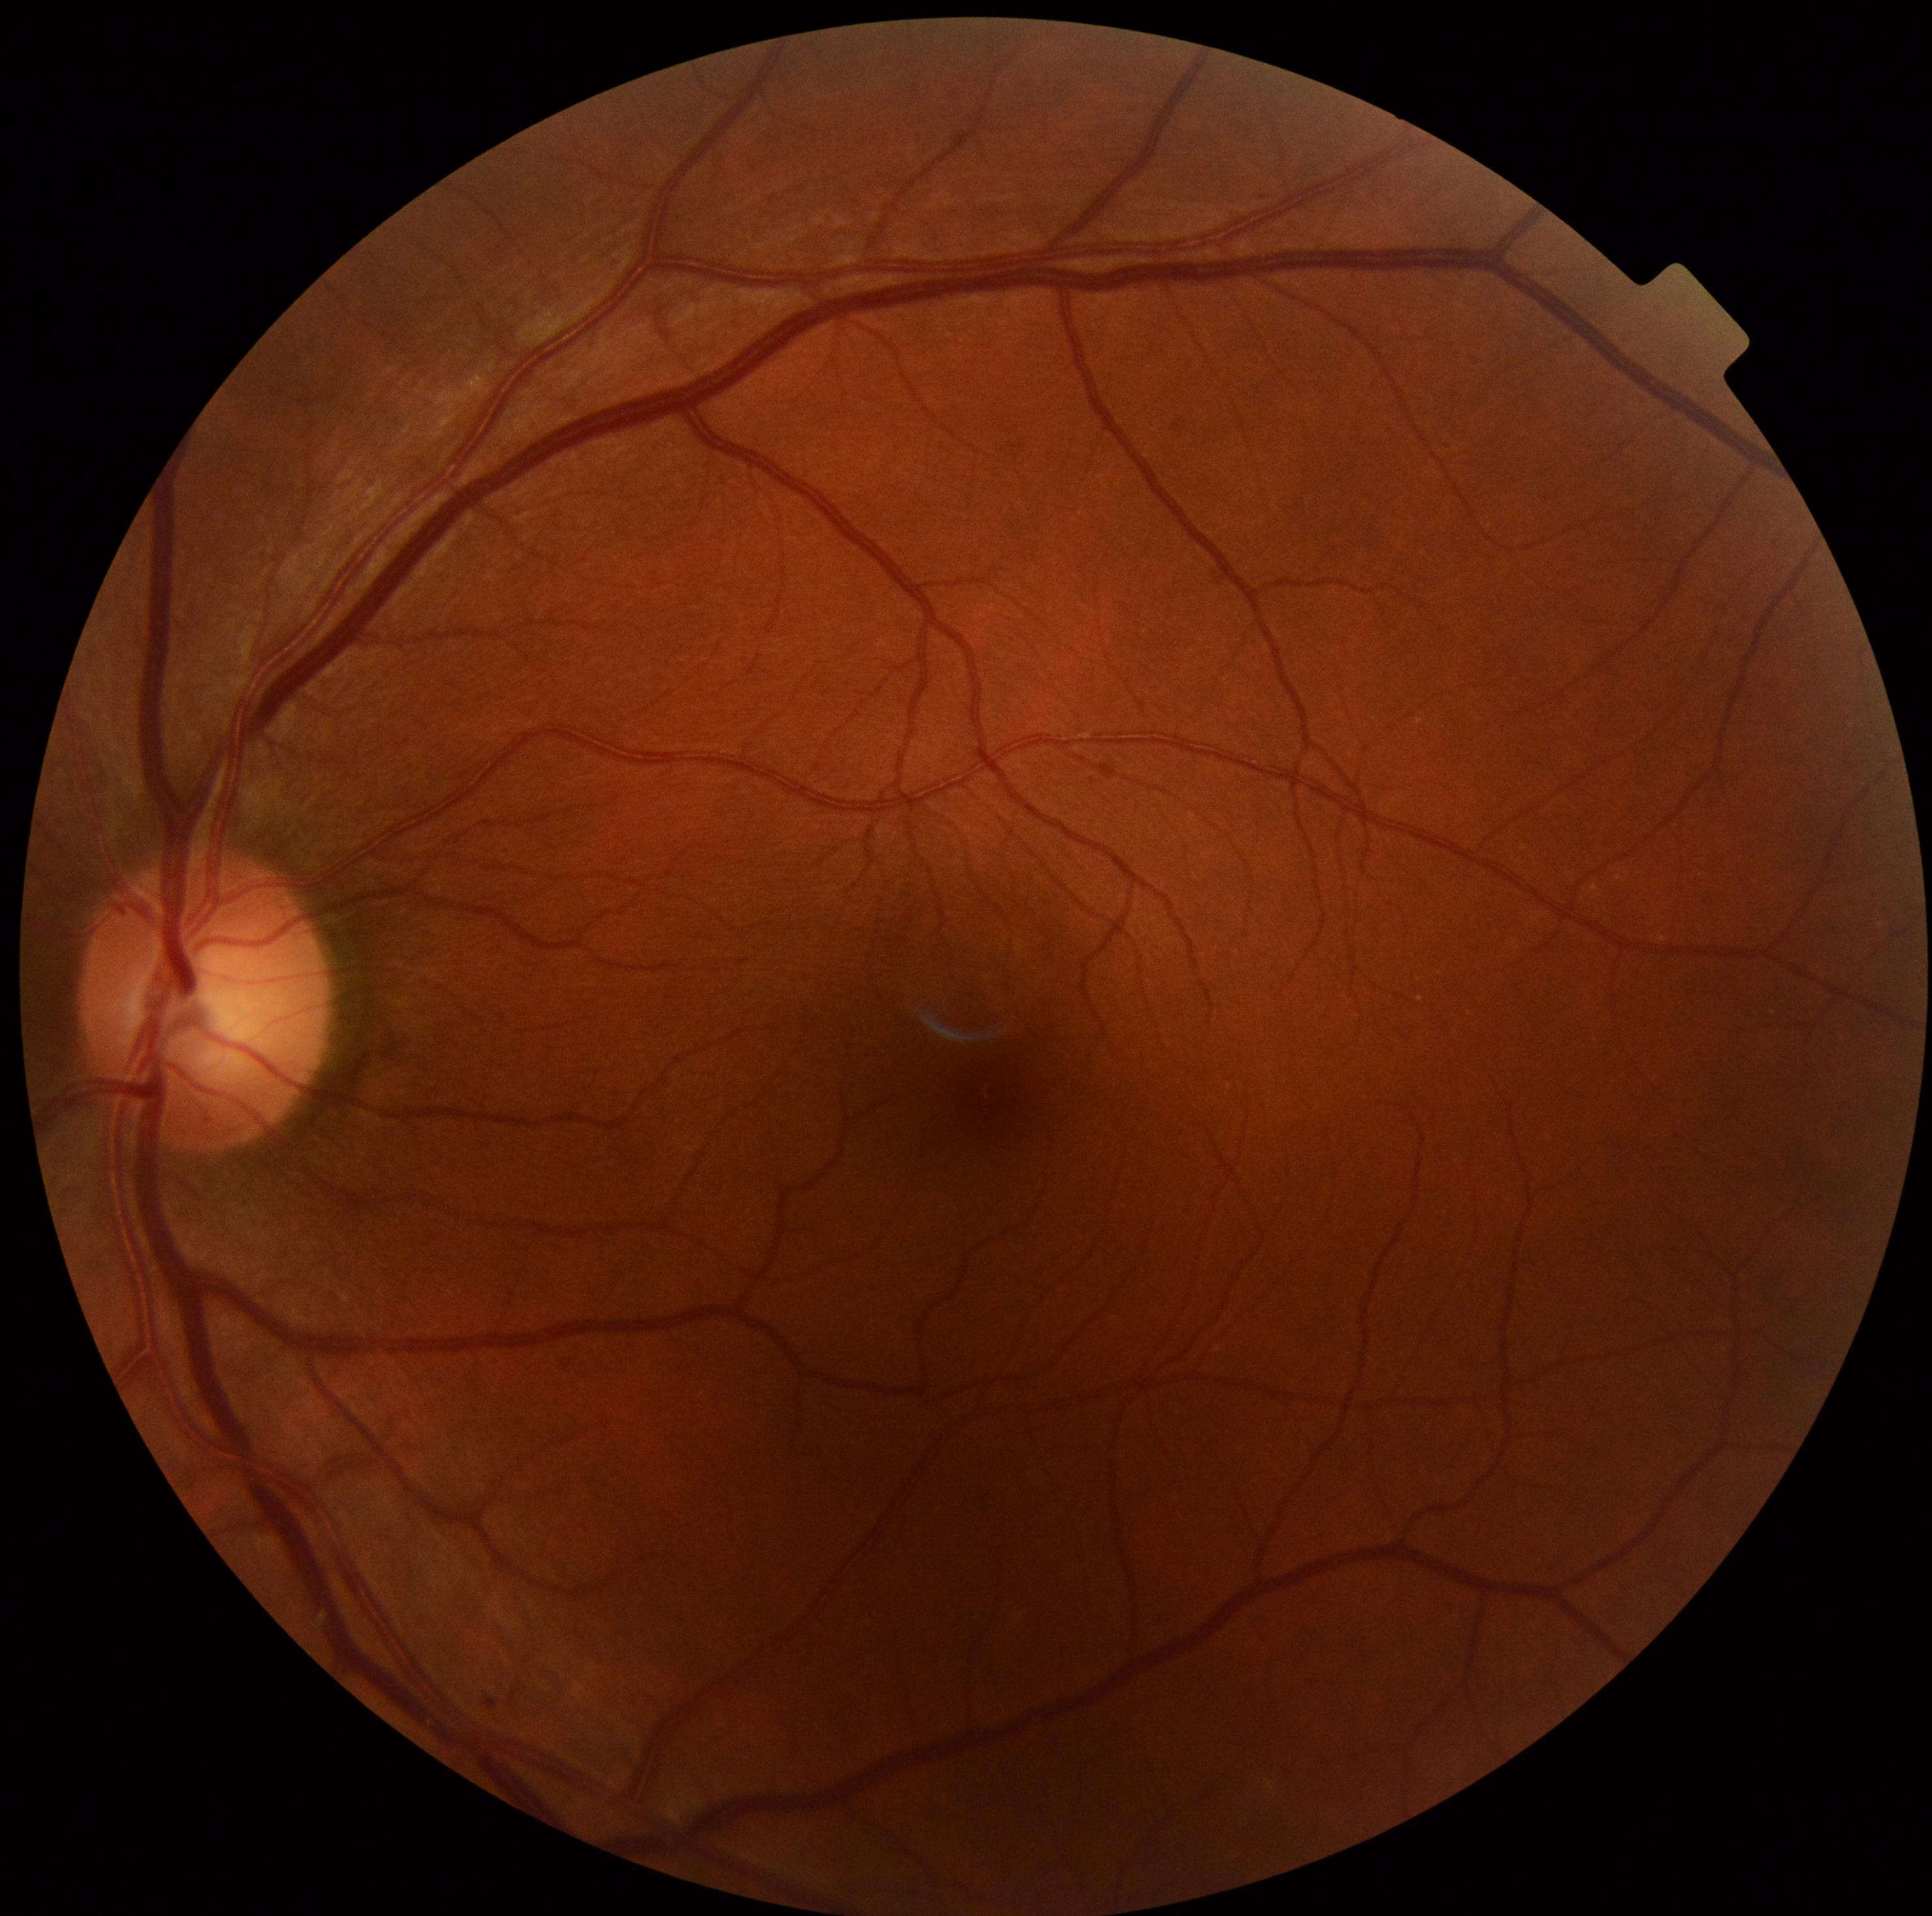
dr_grade: mild NPDR (grade 1)